Pediatric wide-field fundus photograph: 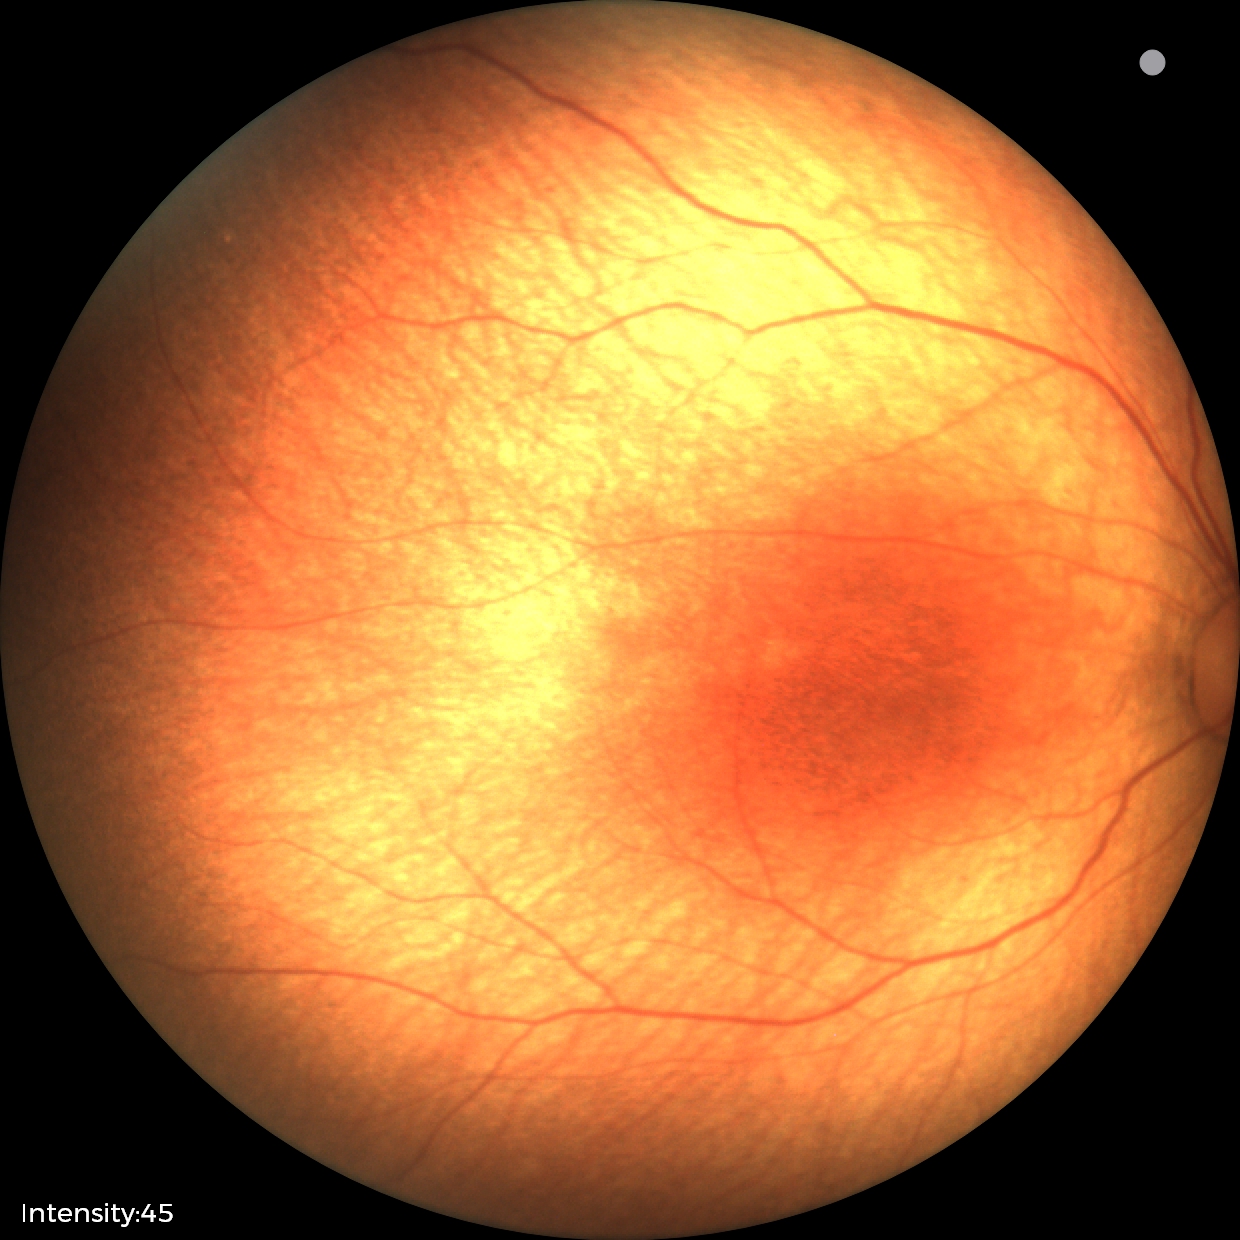 Physiological retinal appearance for postconceptual age.